45-degree field of view:
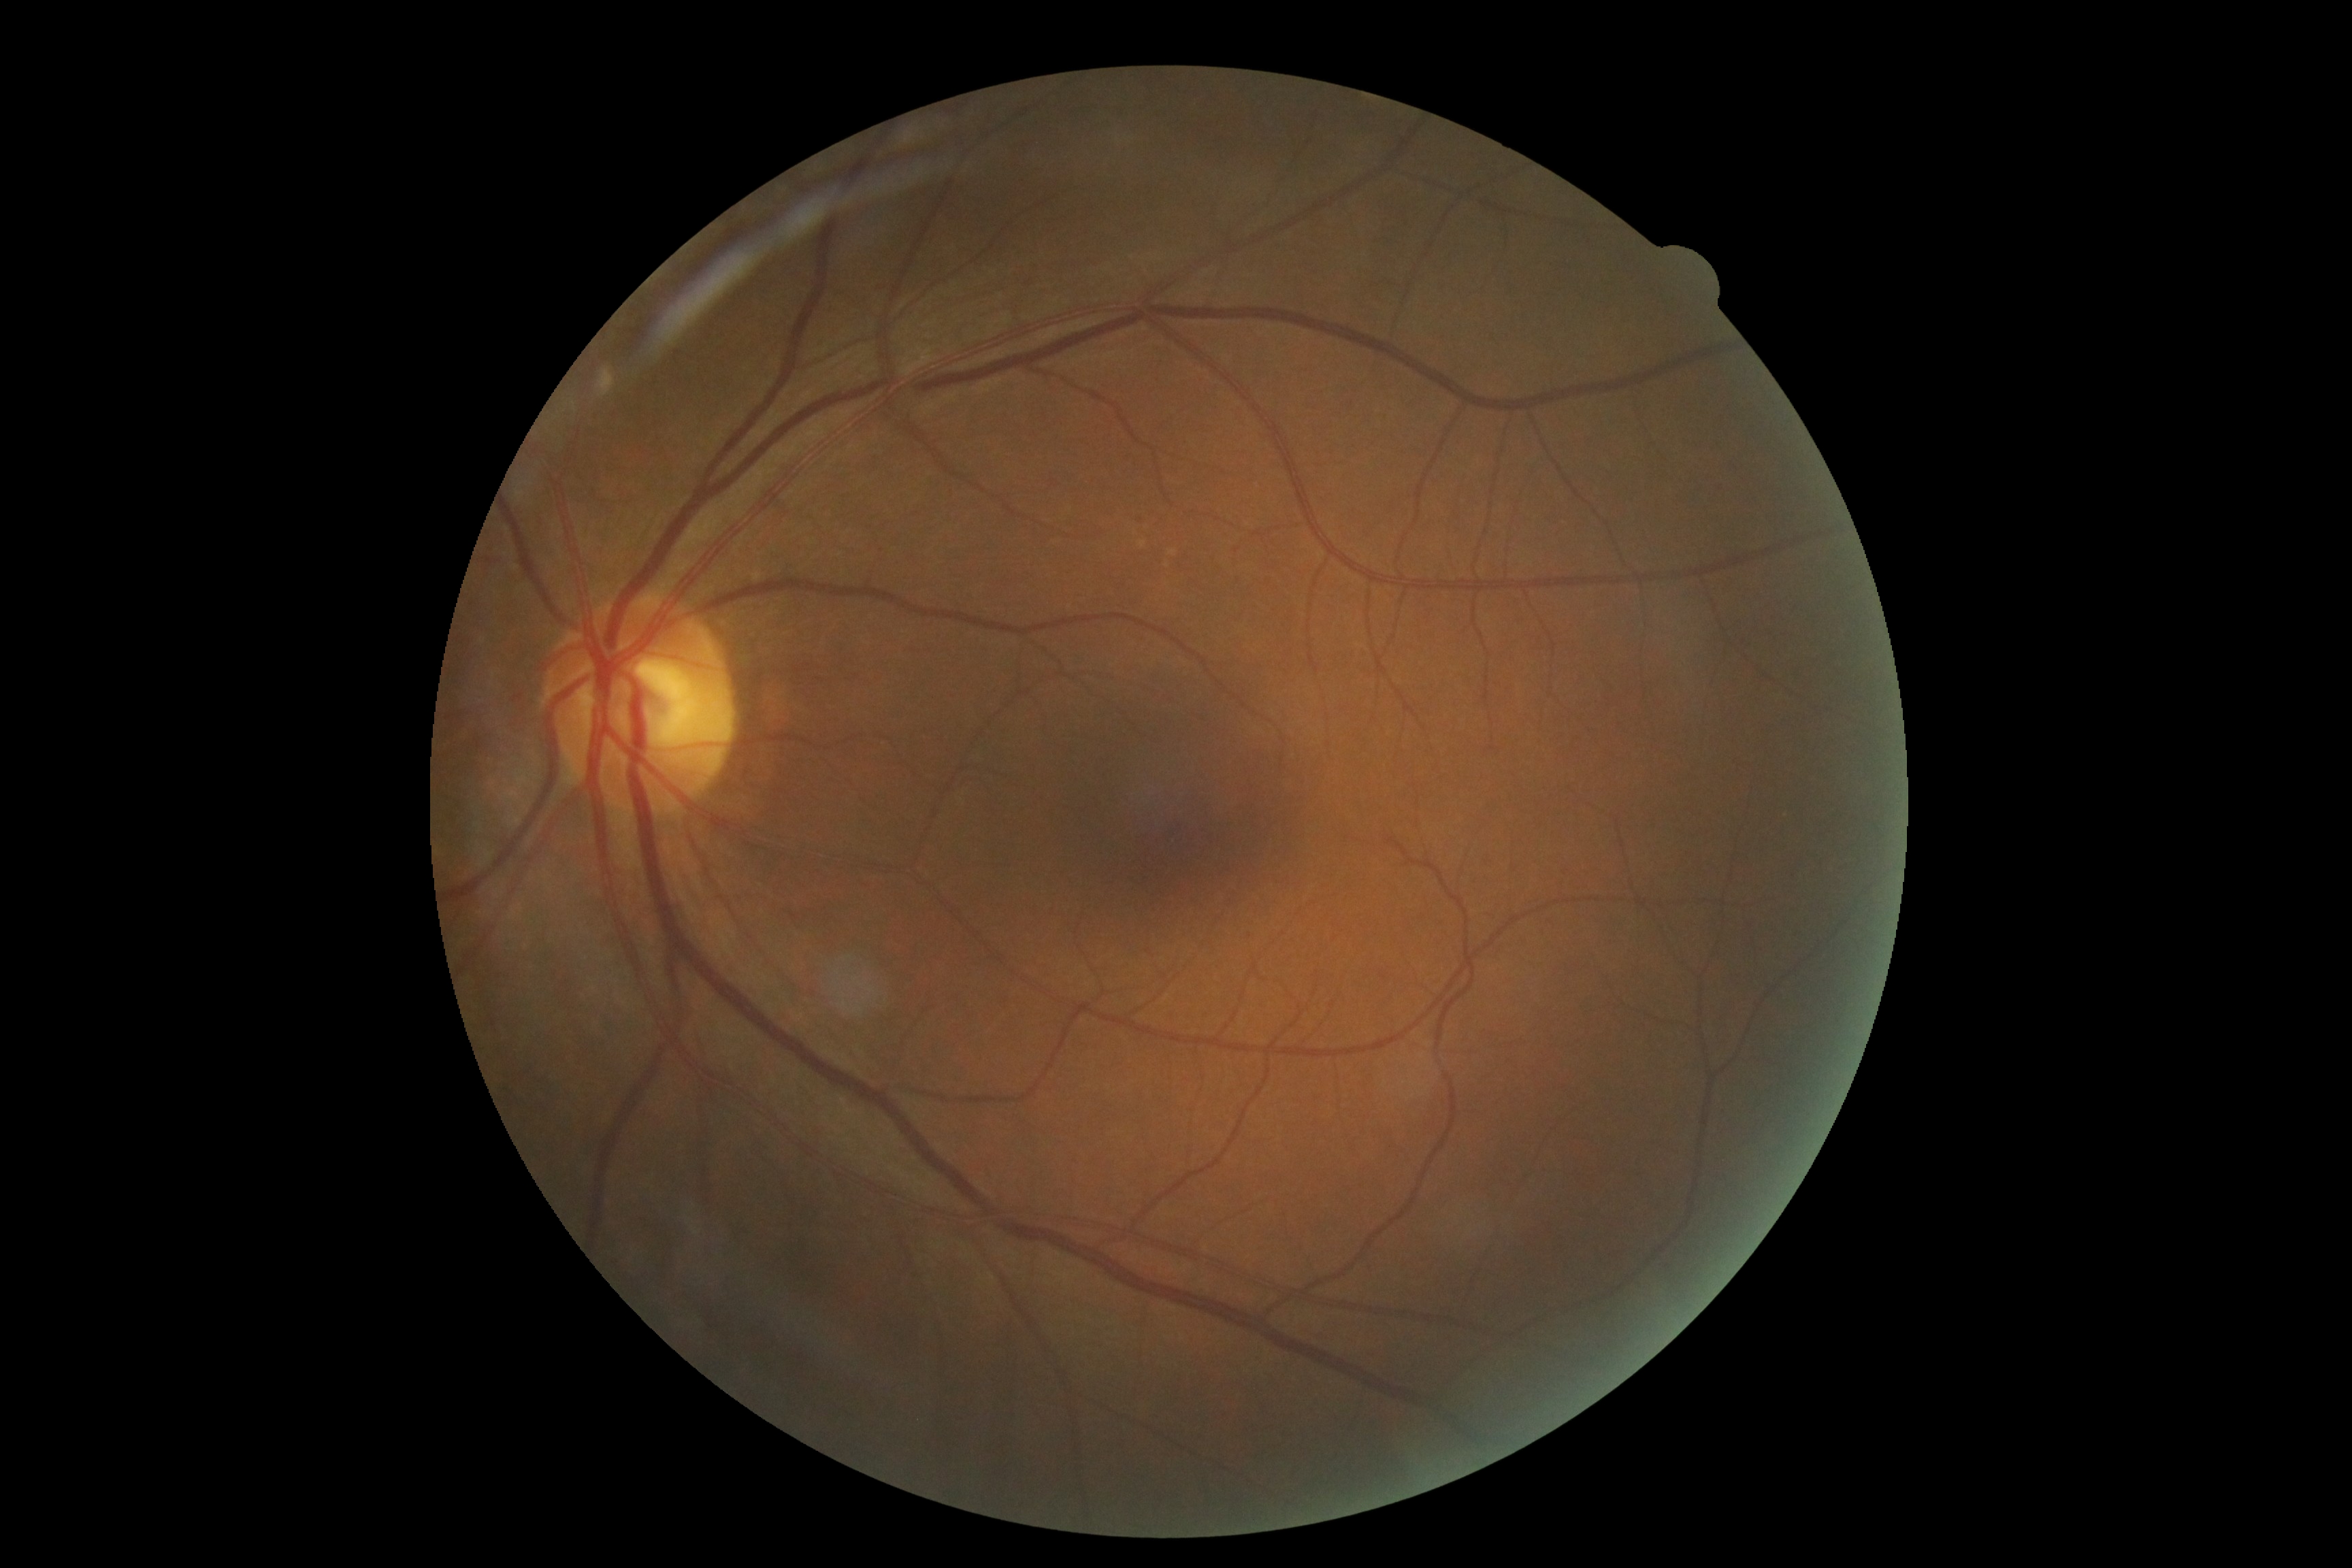 diabetic retinopathy (DR): no apparent diabetic retinopathy (grade 0).